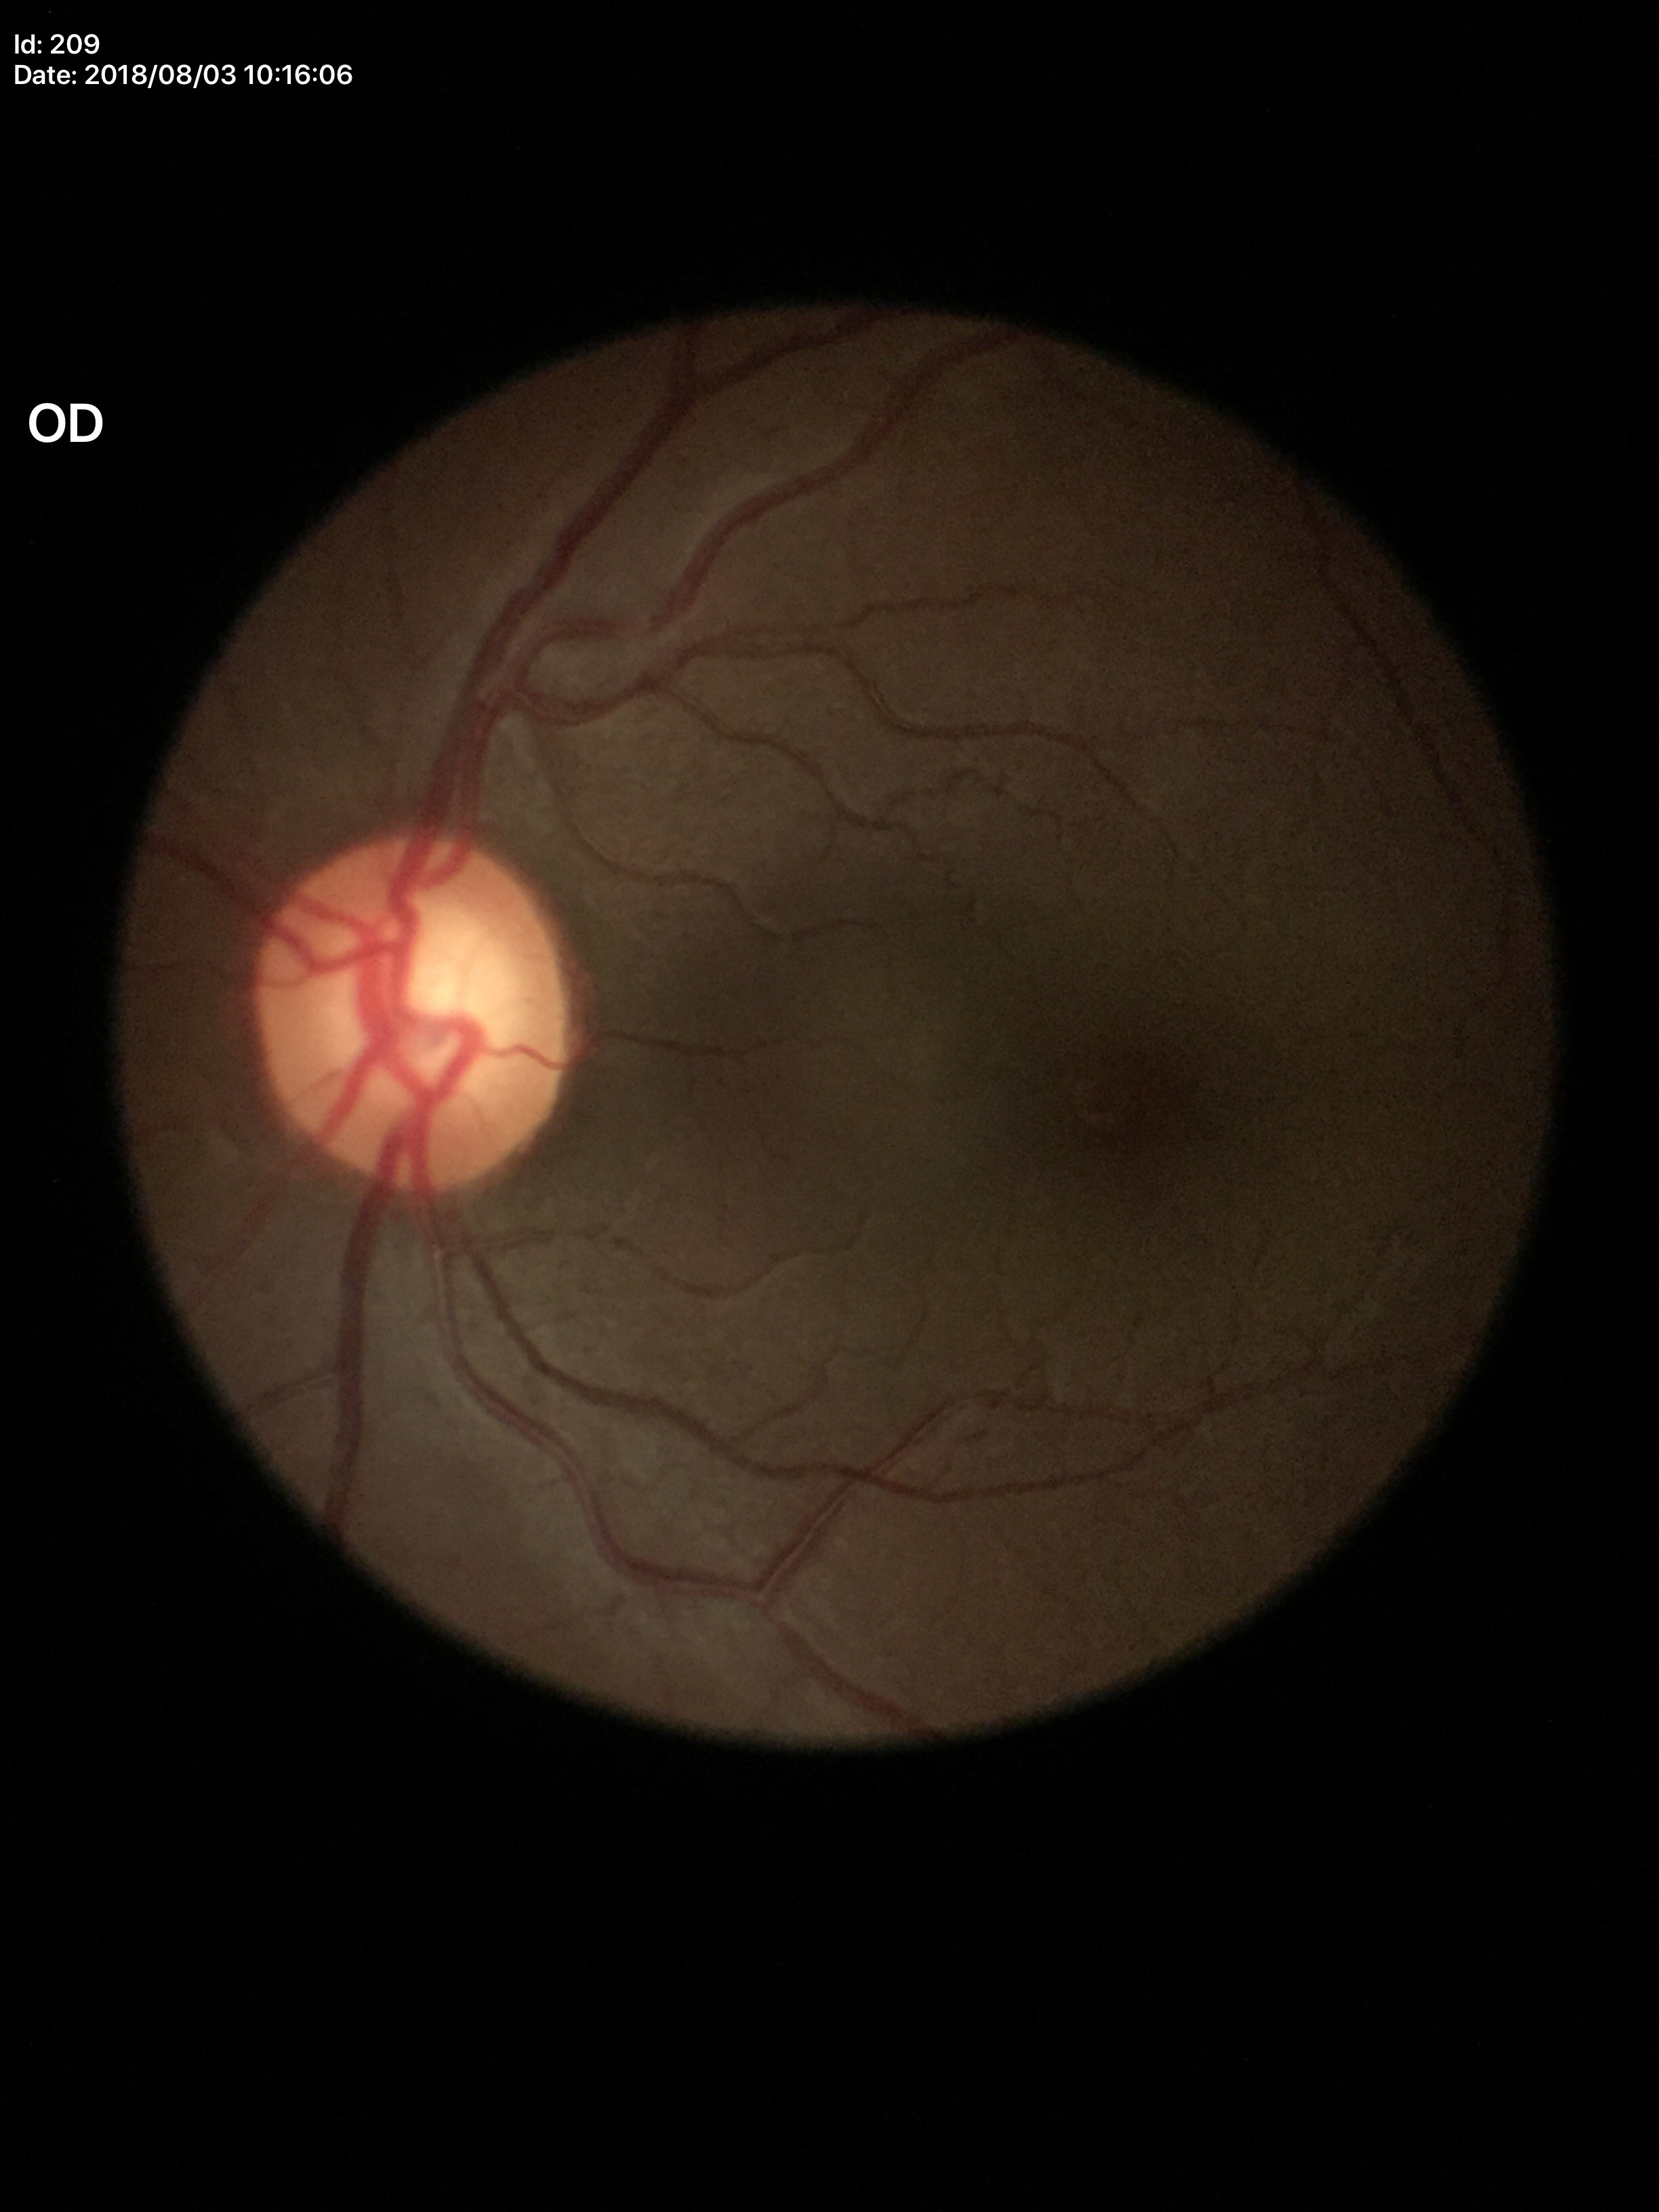

Vertical CDR: 0.64. Glaucoma decision: suspicious findings.